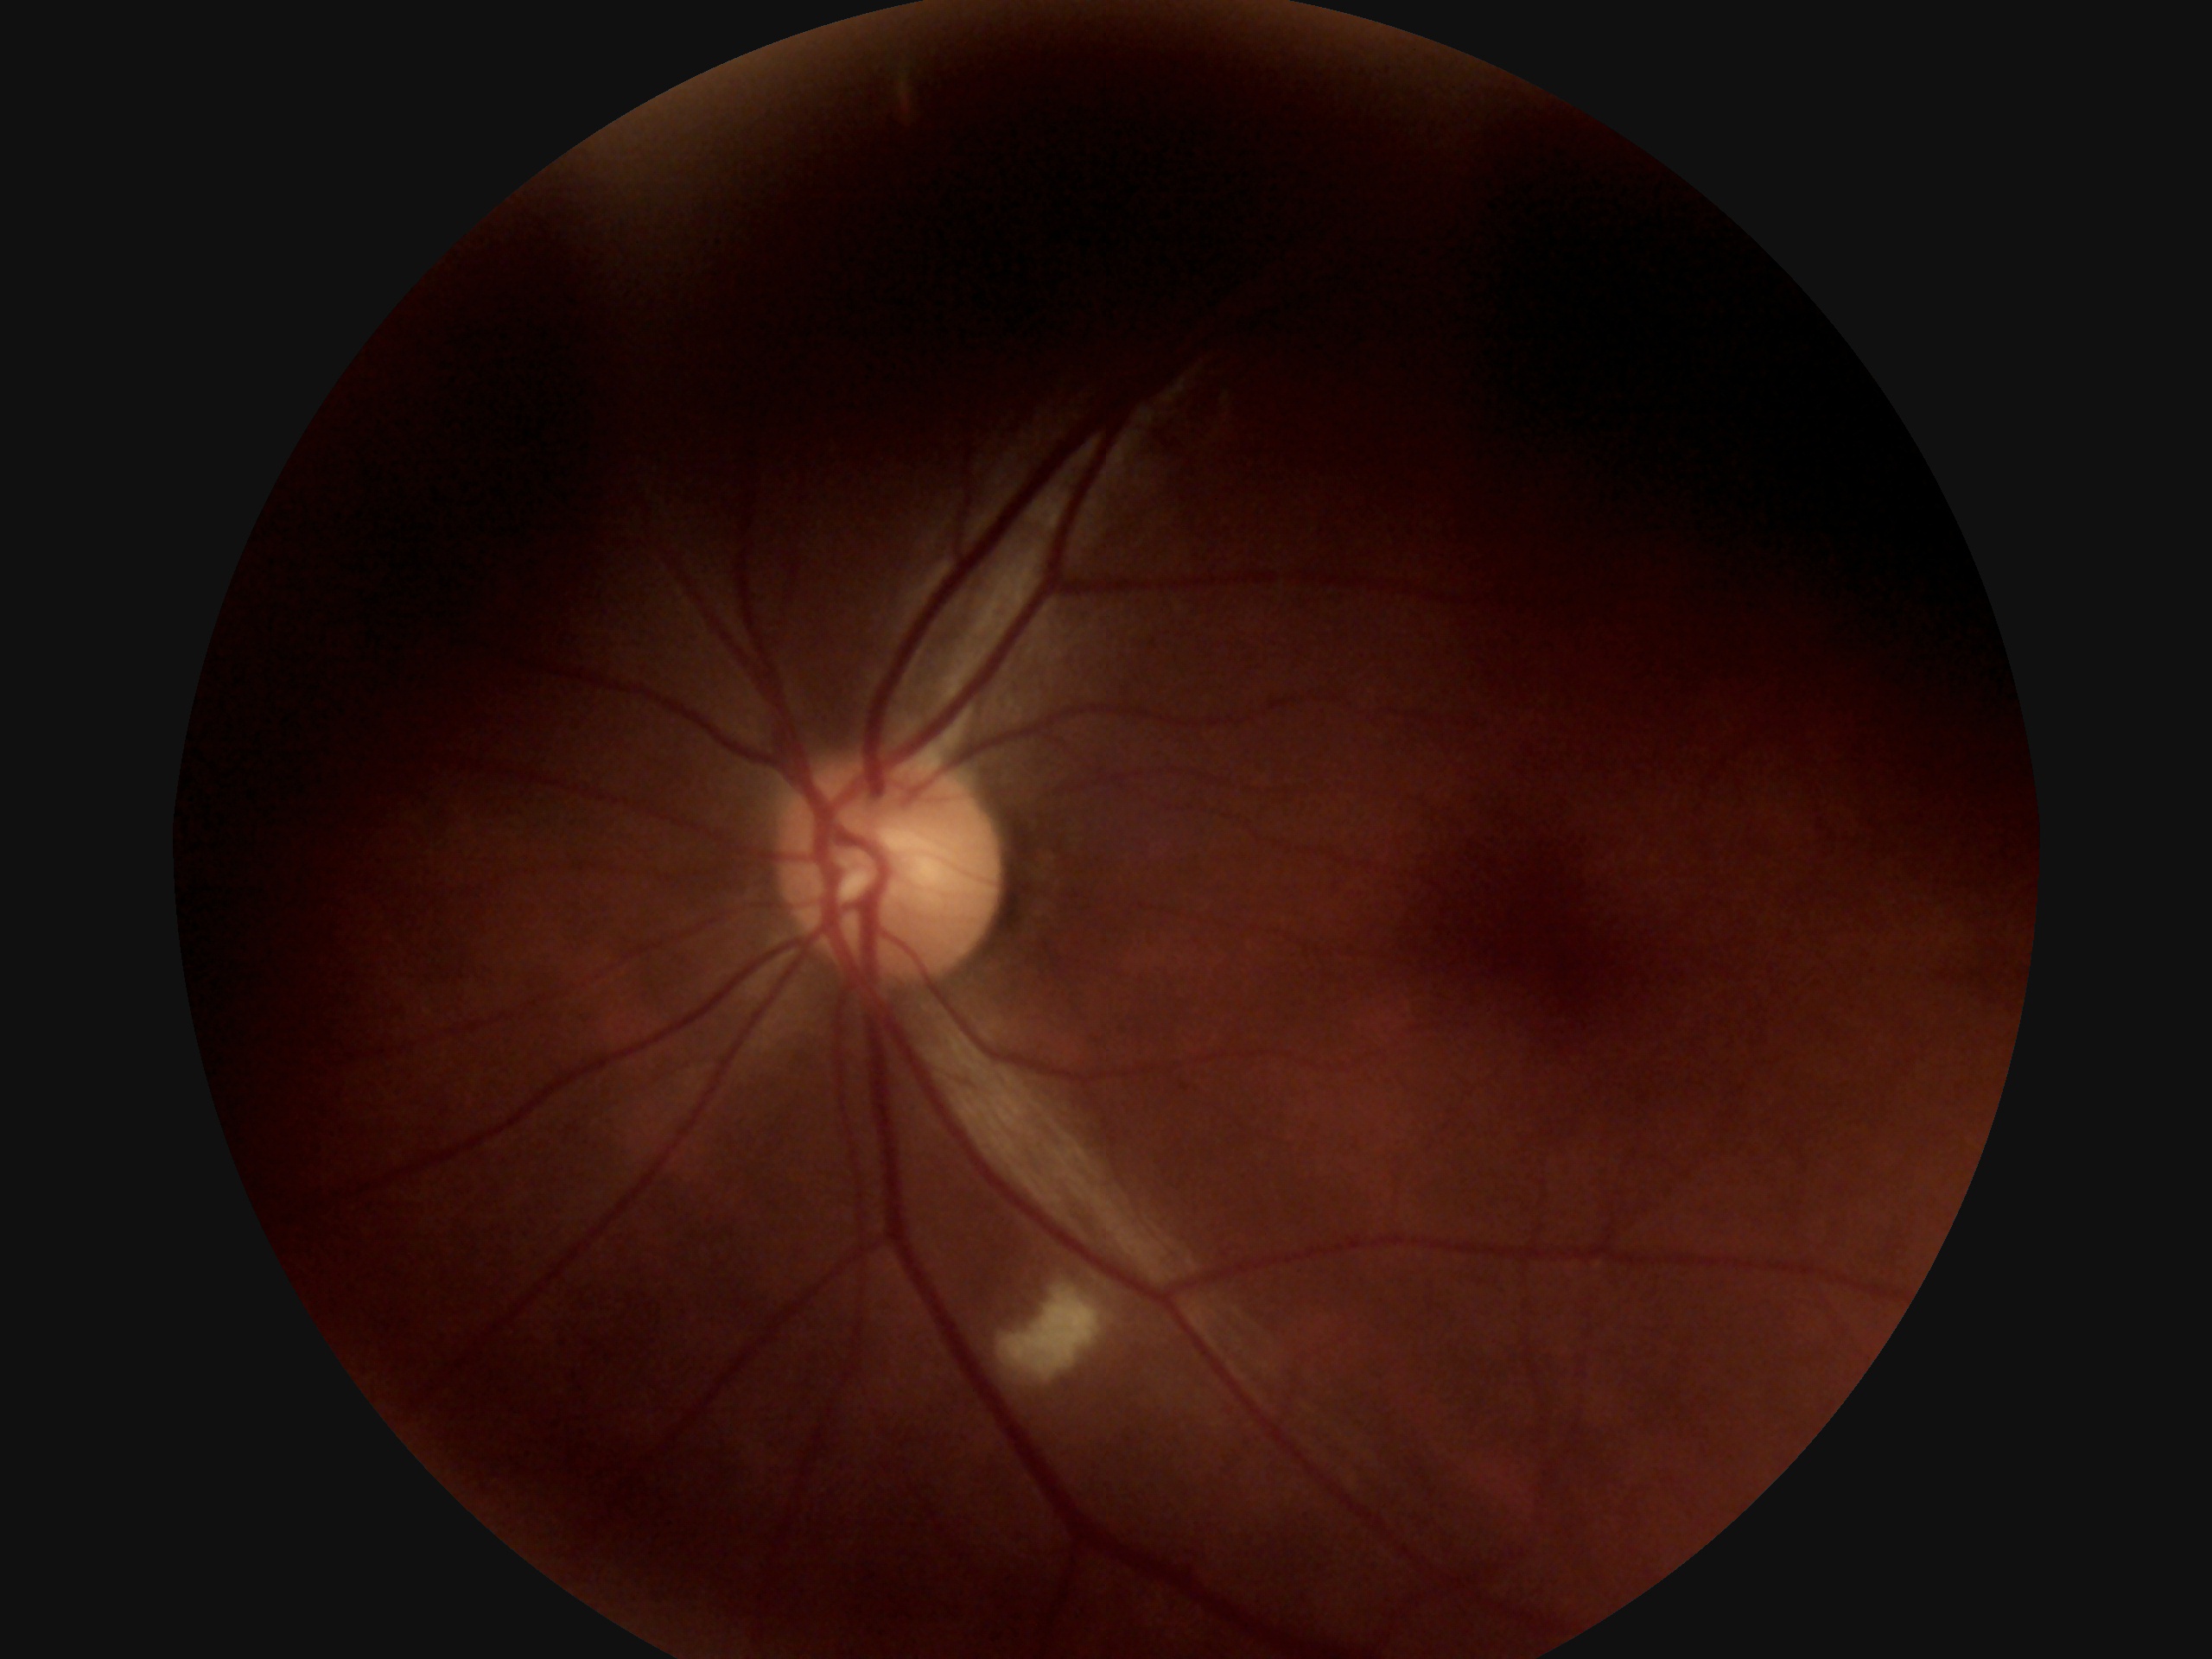
Diabetic retinopathy (DR): grade 2 (moderate NPDR).